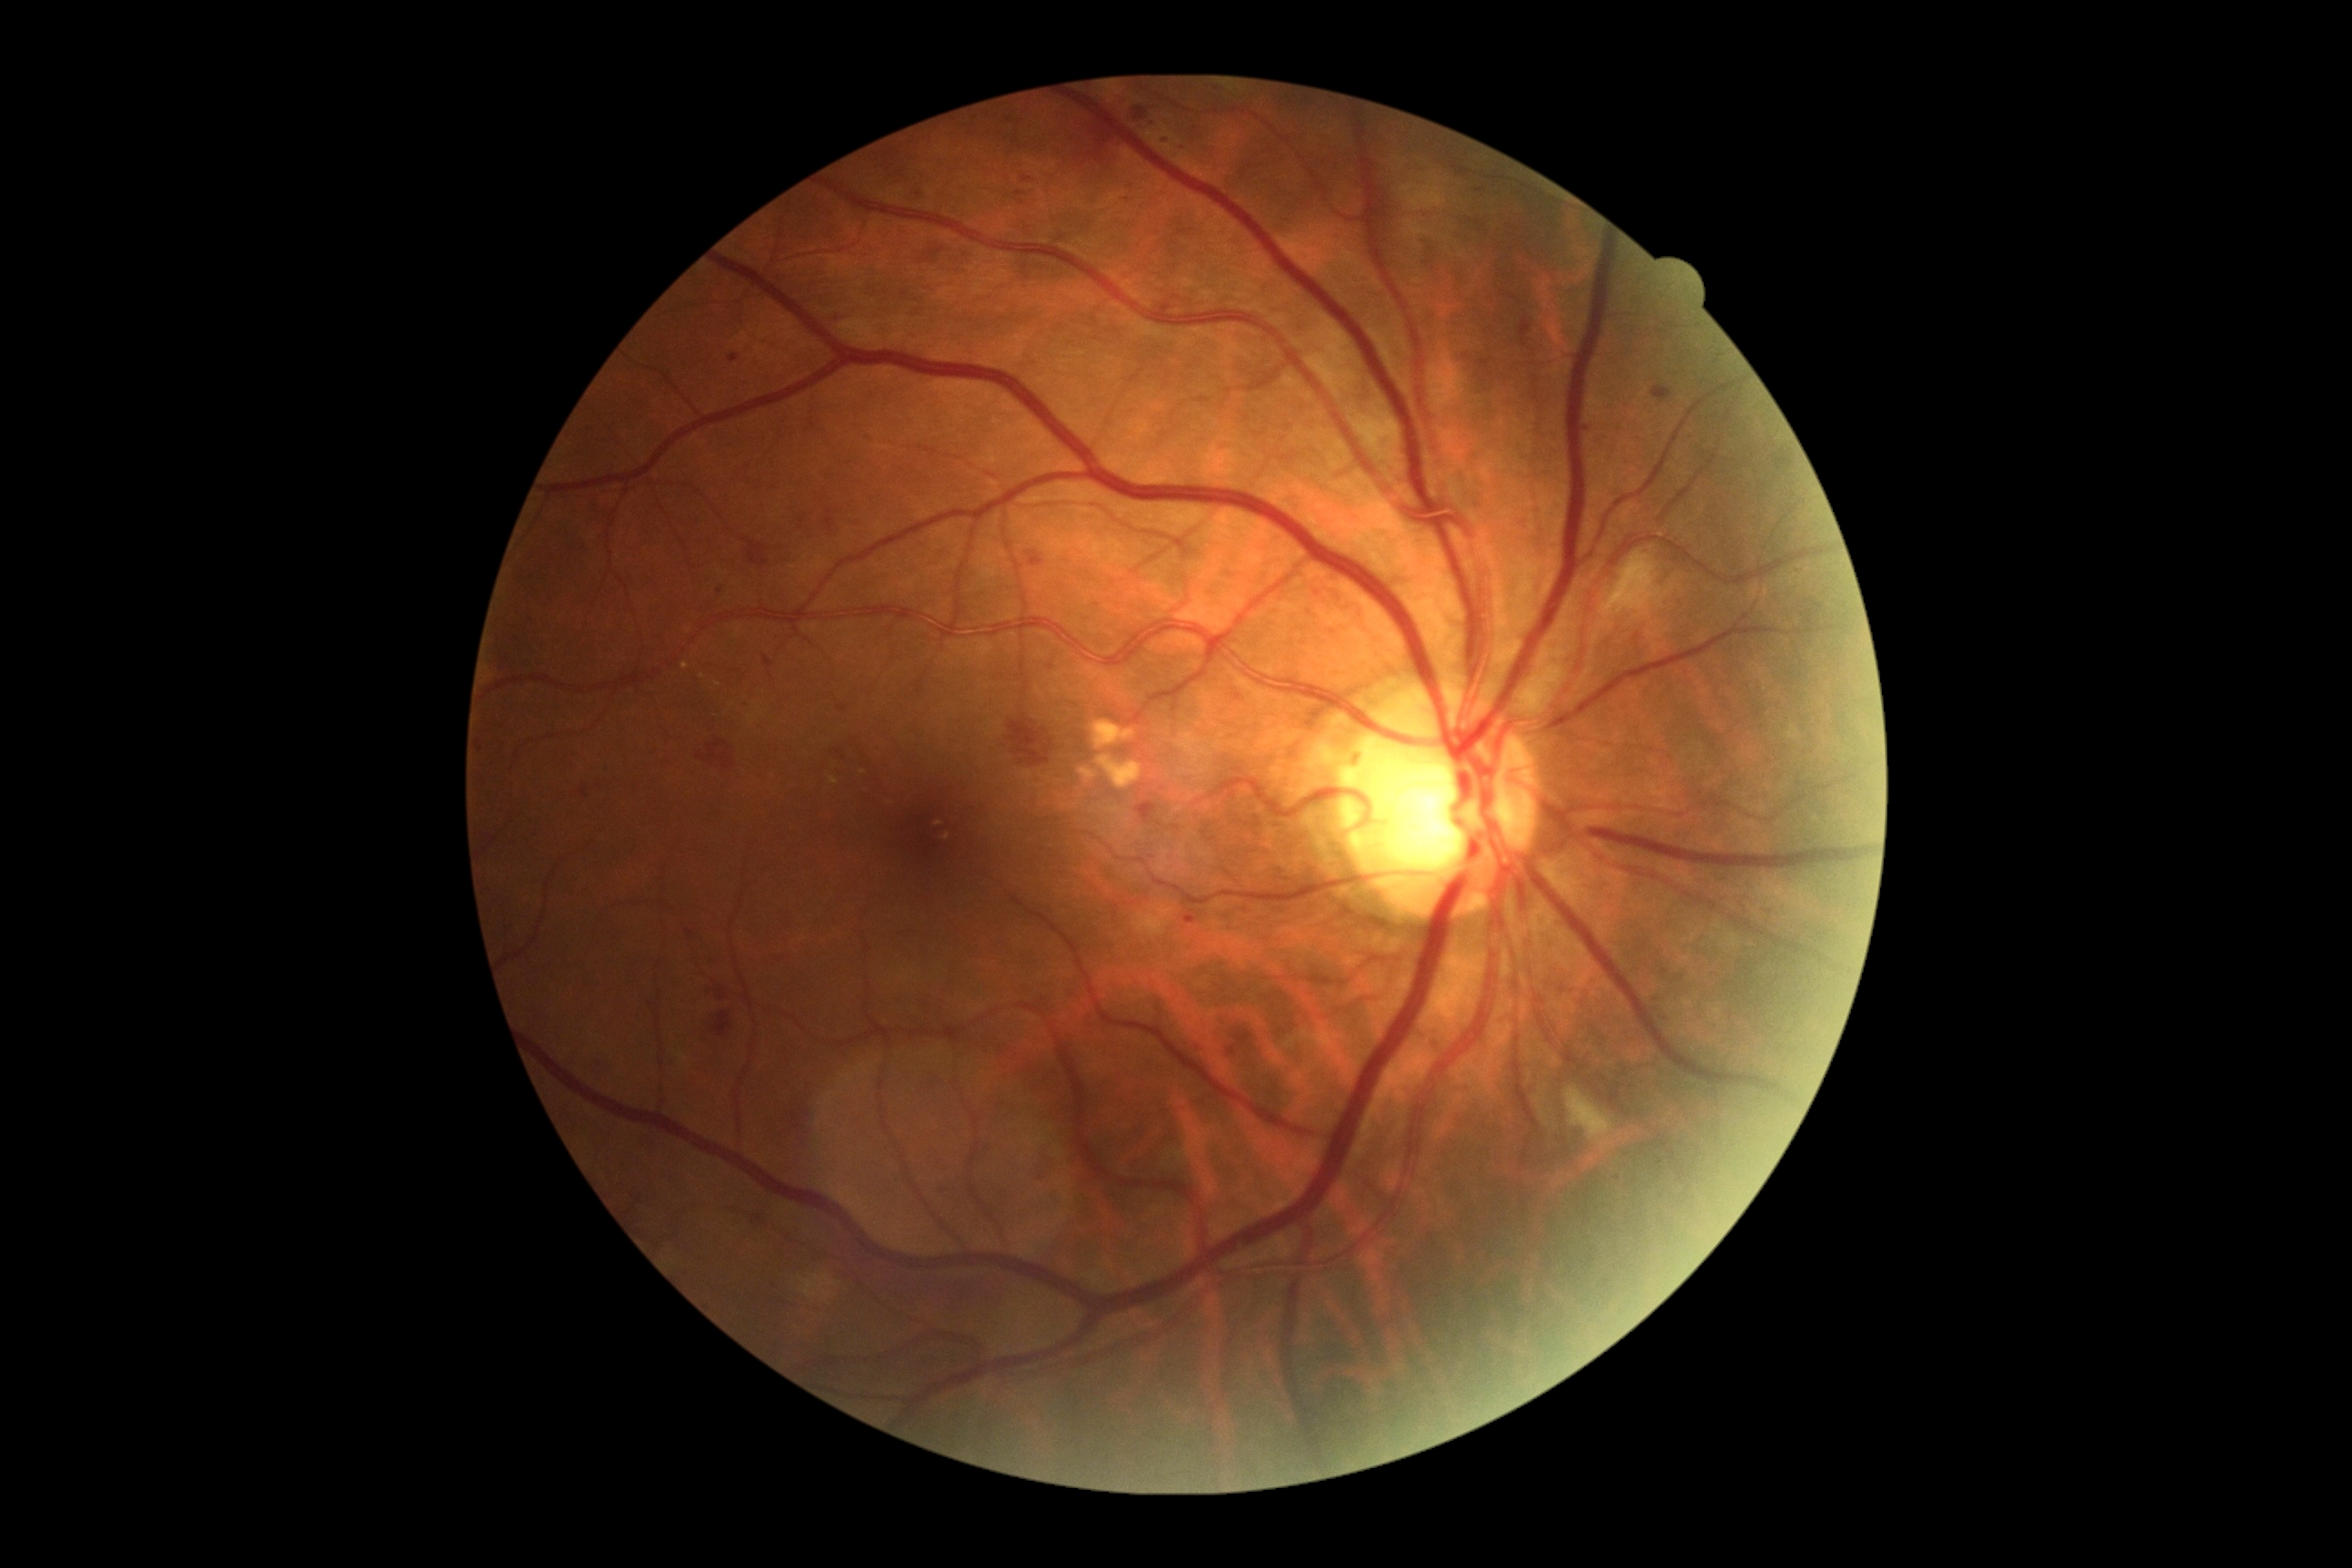
Retinopathy grade: 2. DR class: non-proliferative diabetic retinopathy.